1380 x 1382 pixels — 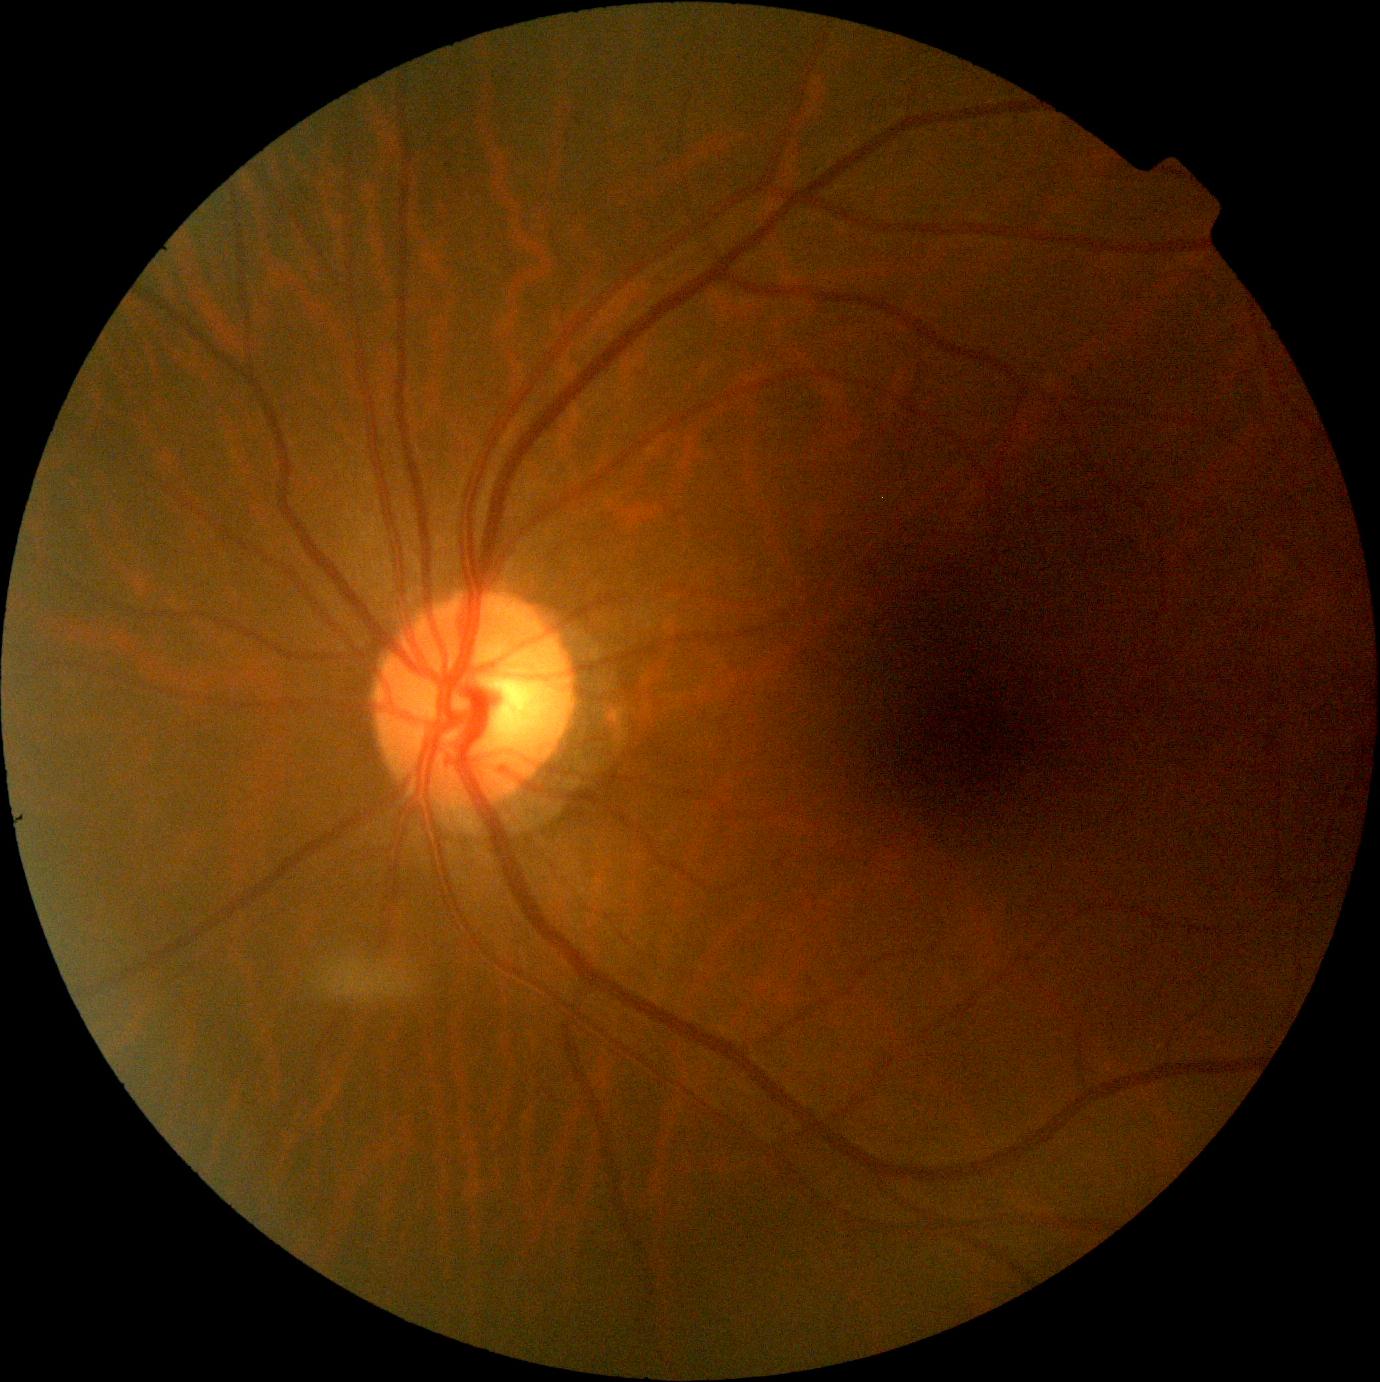 DR is grade 0. No signs of diabetic retinopathy.